Camera: NIDEK AFC-230 · retinal fundus photograph.
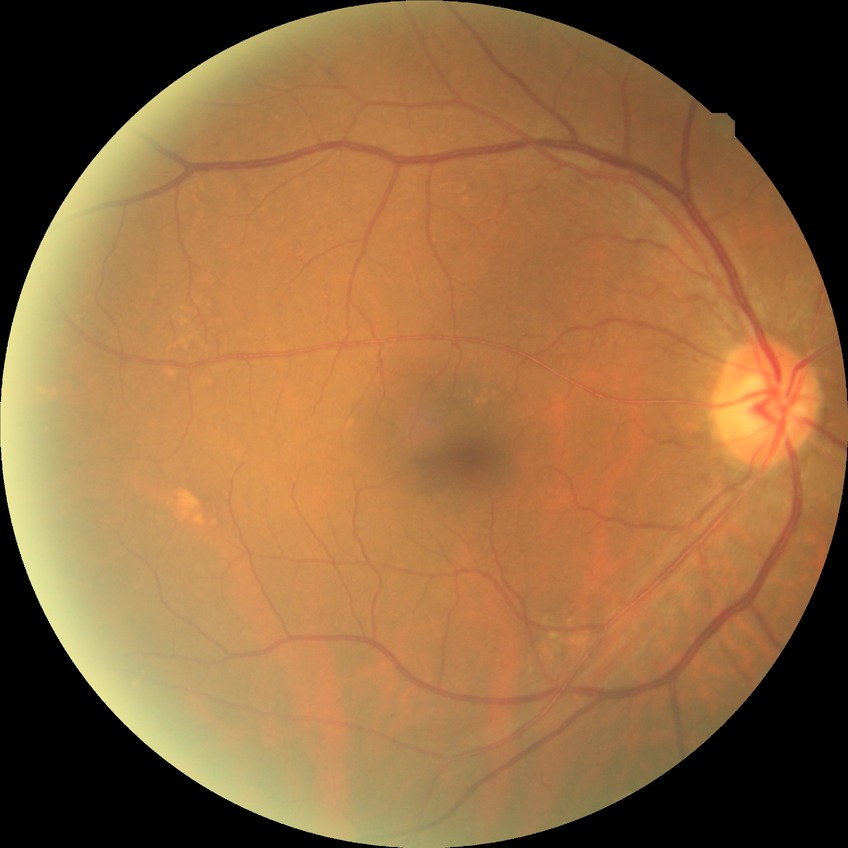 No signs of diabetic retinopathy. Davis DR grade: NDR.